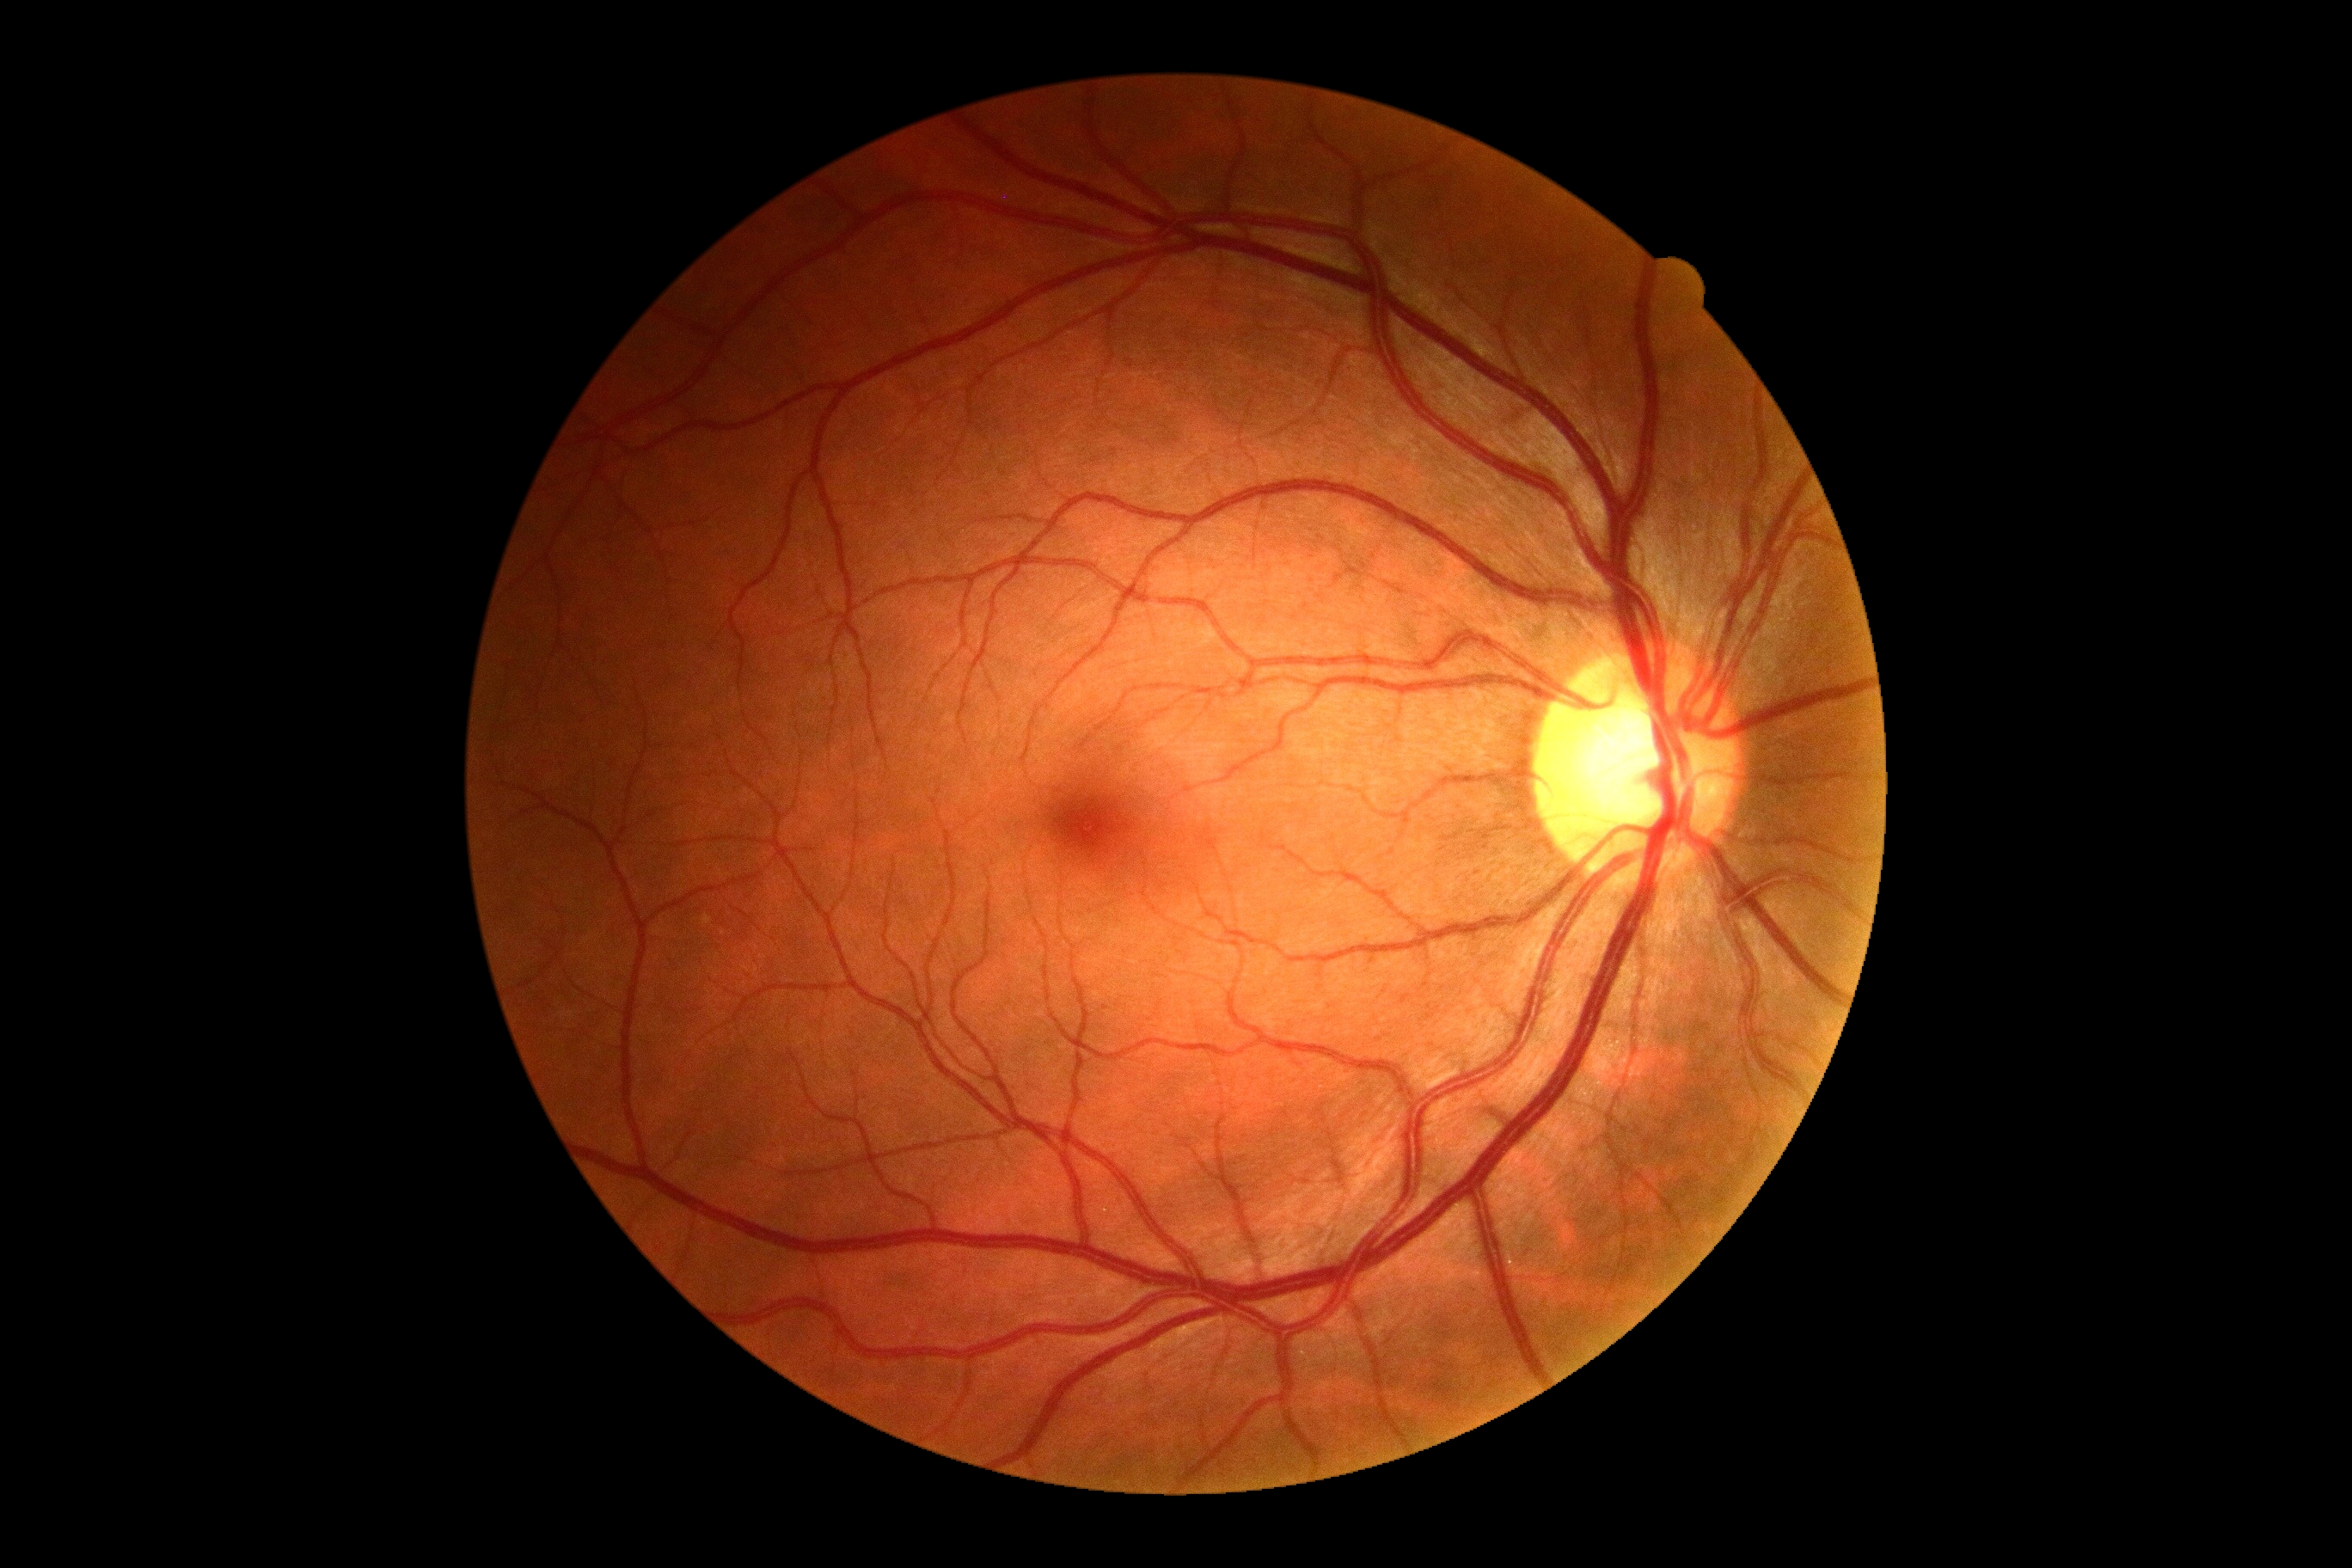

Retinopathy is 0/4.